Image size 2352x1568 · fundus photo · 45° field of view — 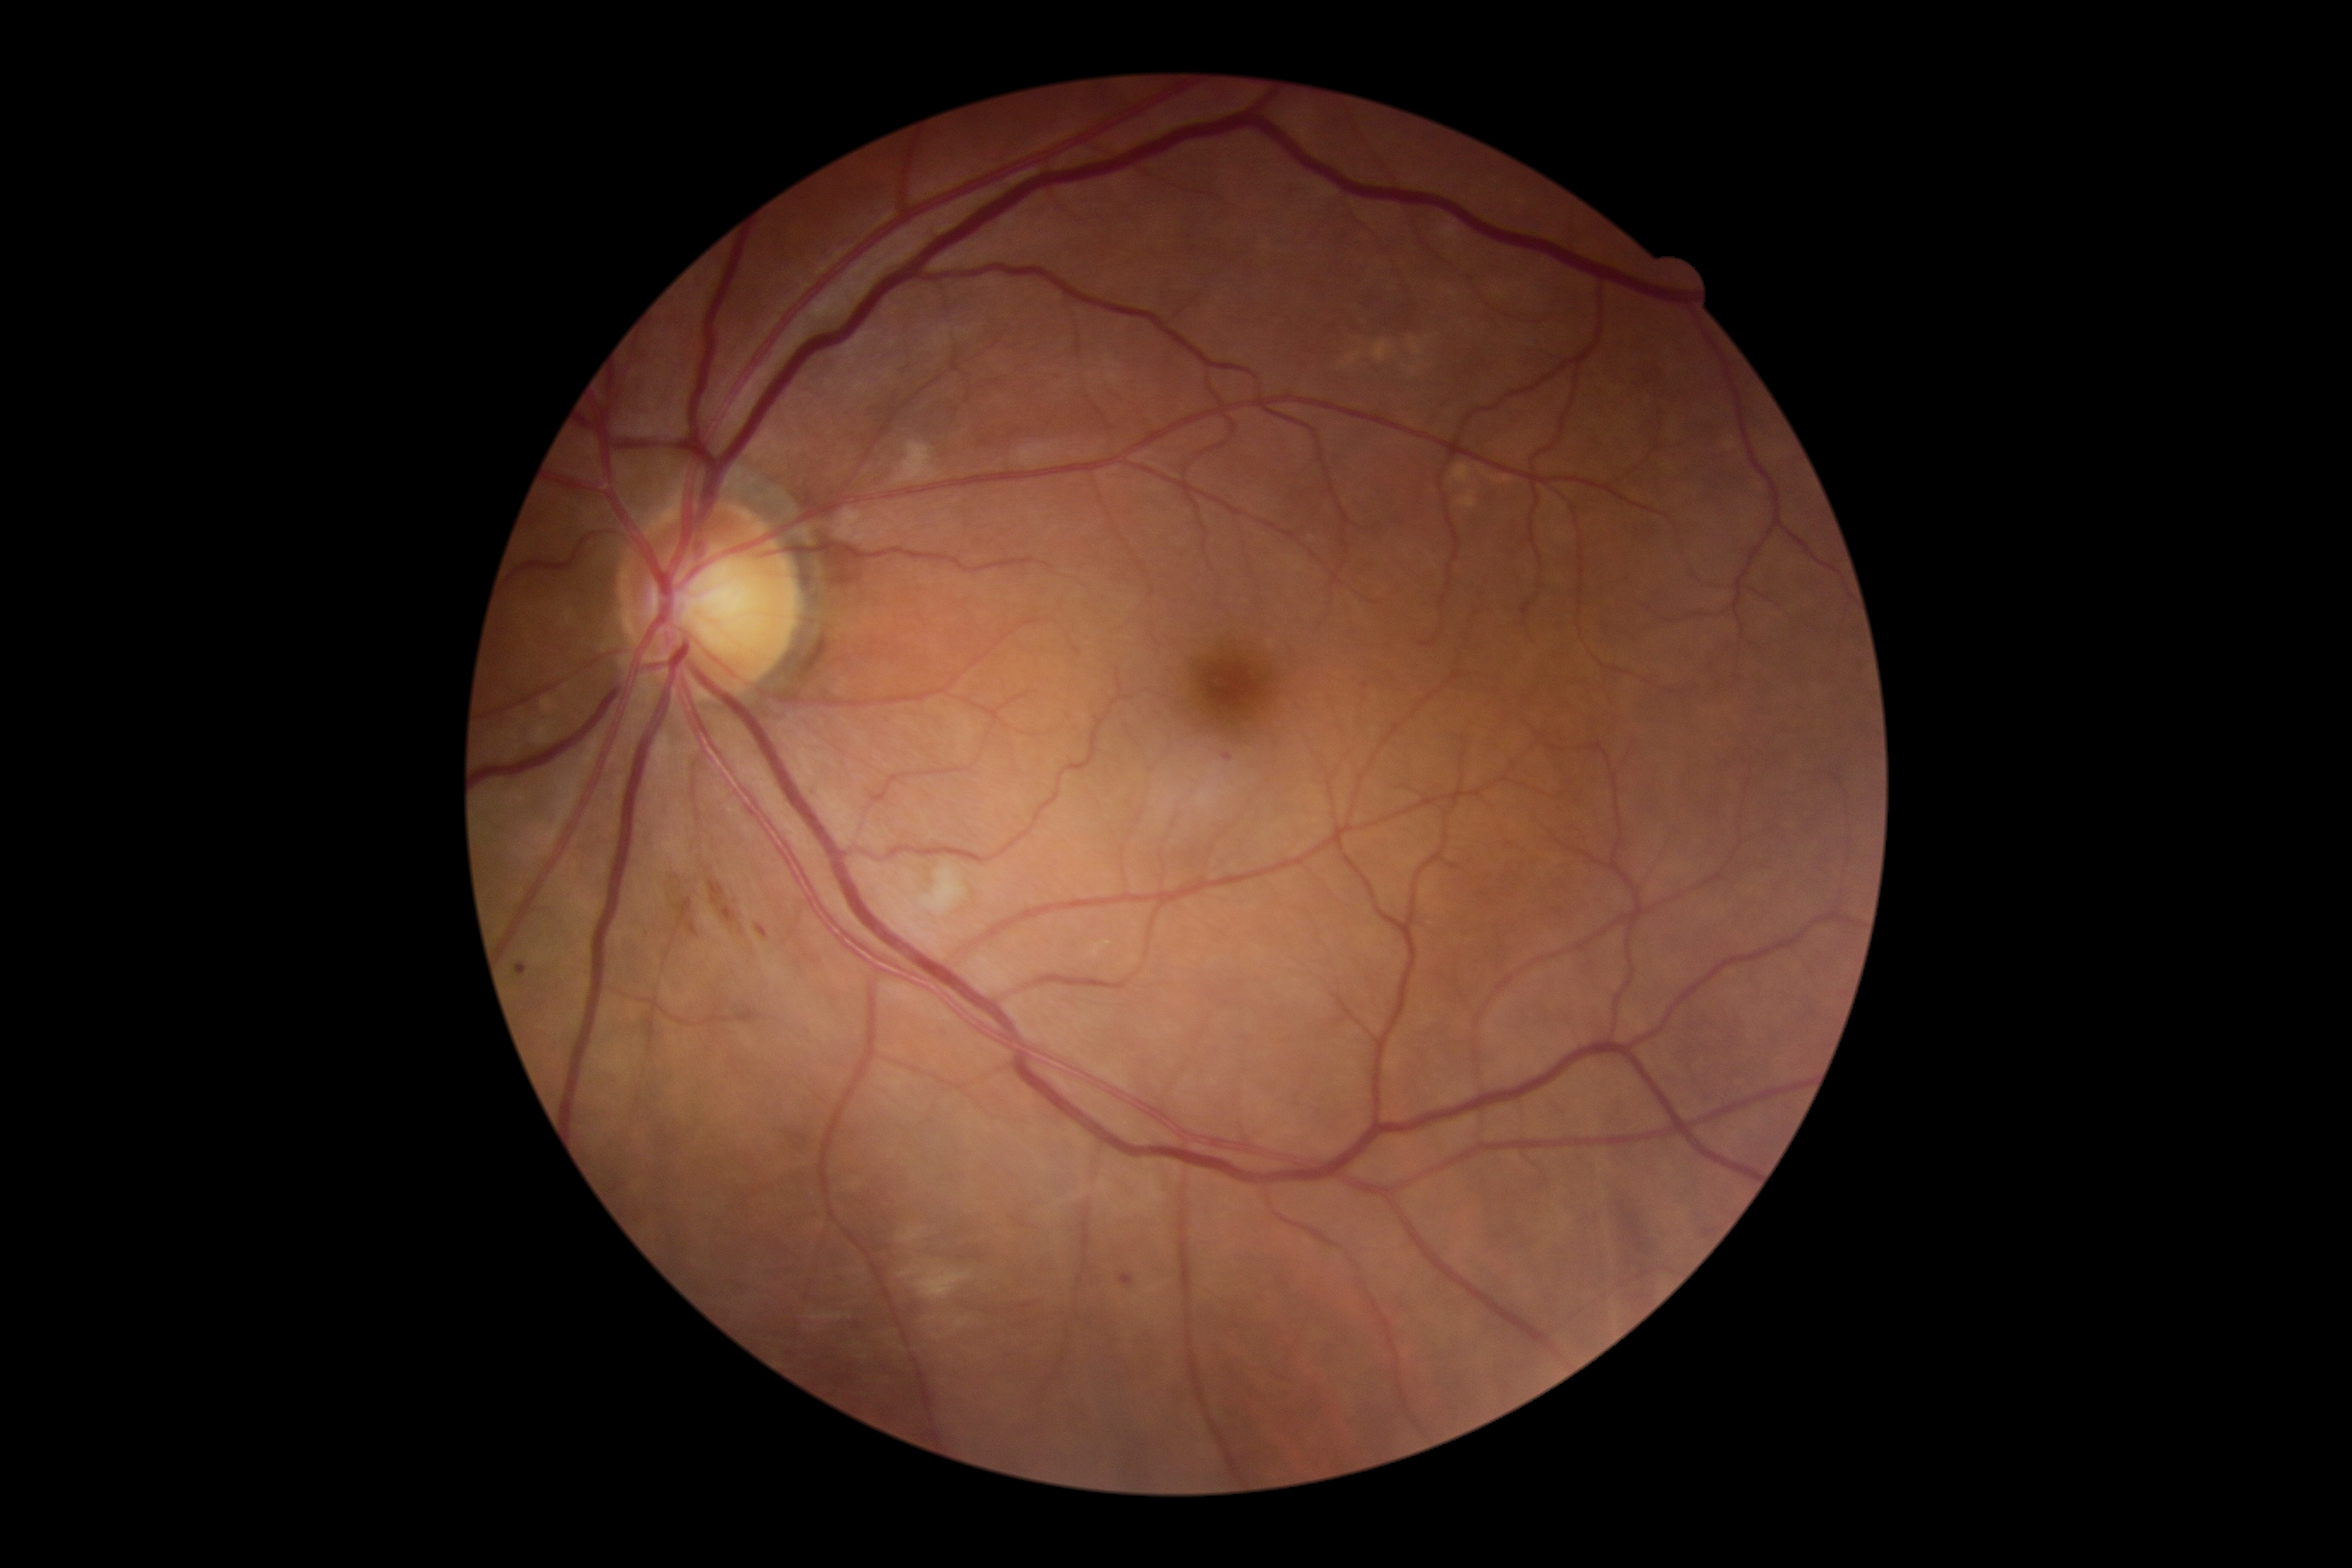
DR severity: 2.
The retinopathy is classified as non-proliferative diabetic retinopathy.